Without pupil dilation, modified Davis grading:
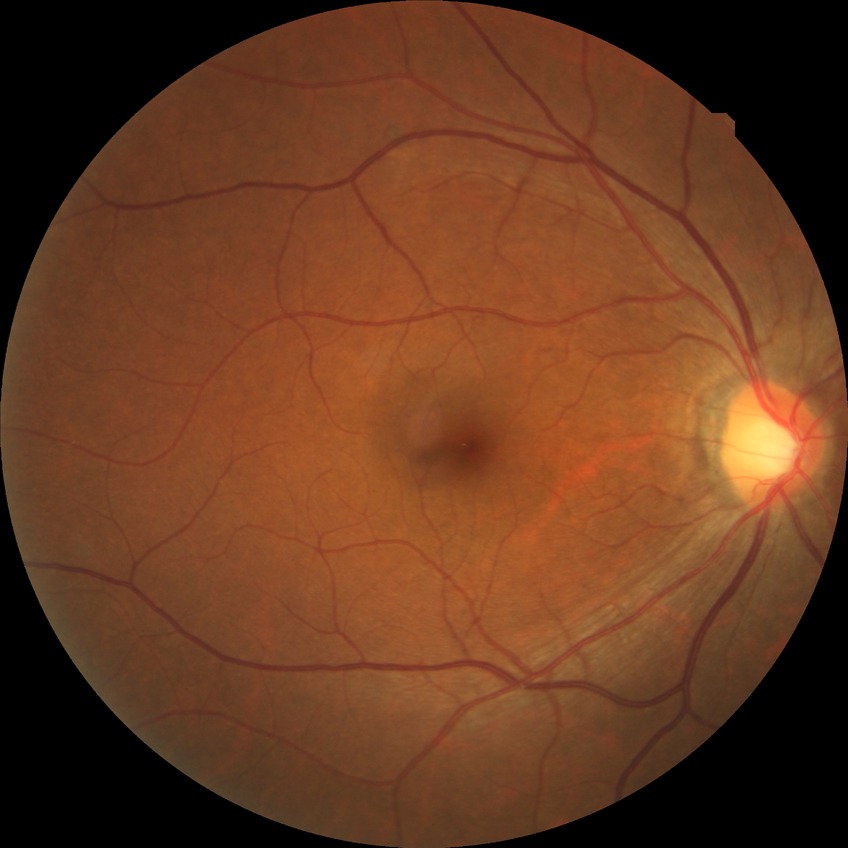

Modified Davis classification is no diabetic retinopathy.